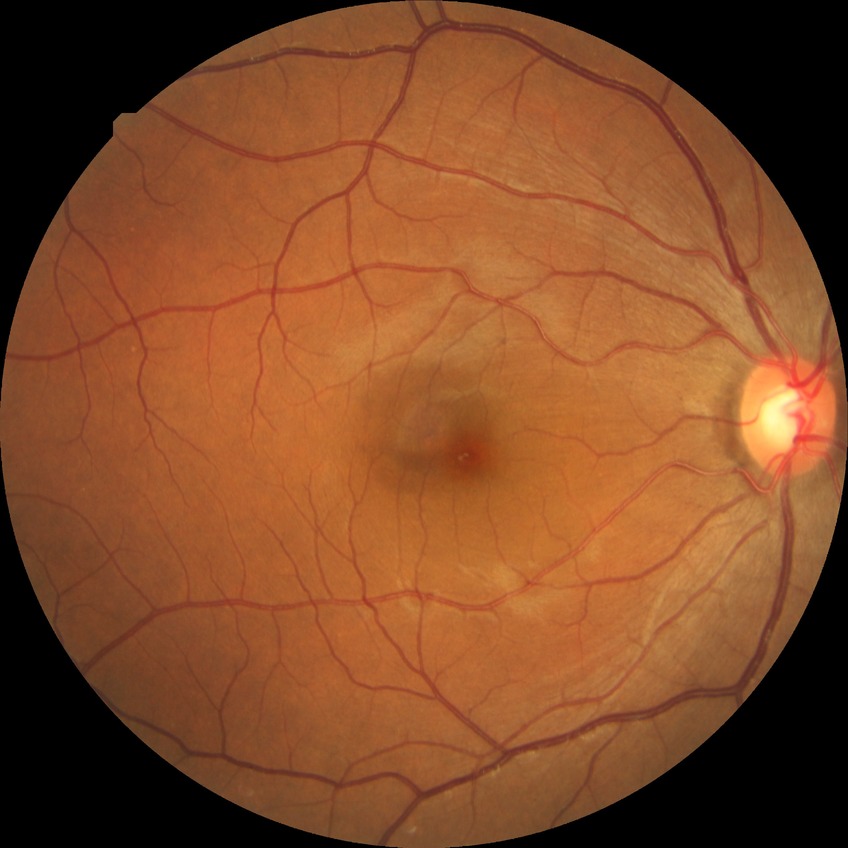   davis_grade: NDR (no diabetic retinopathy)